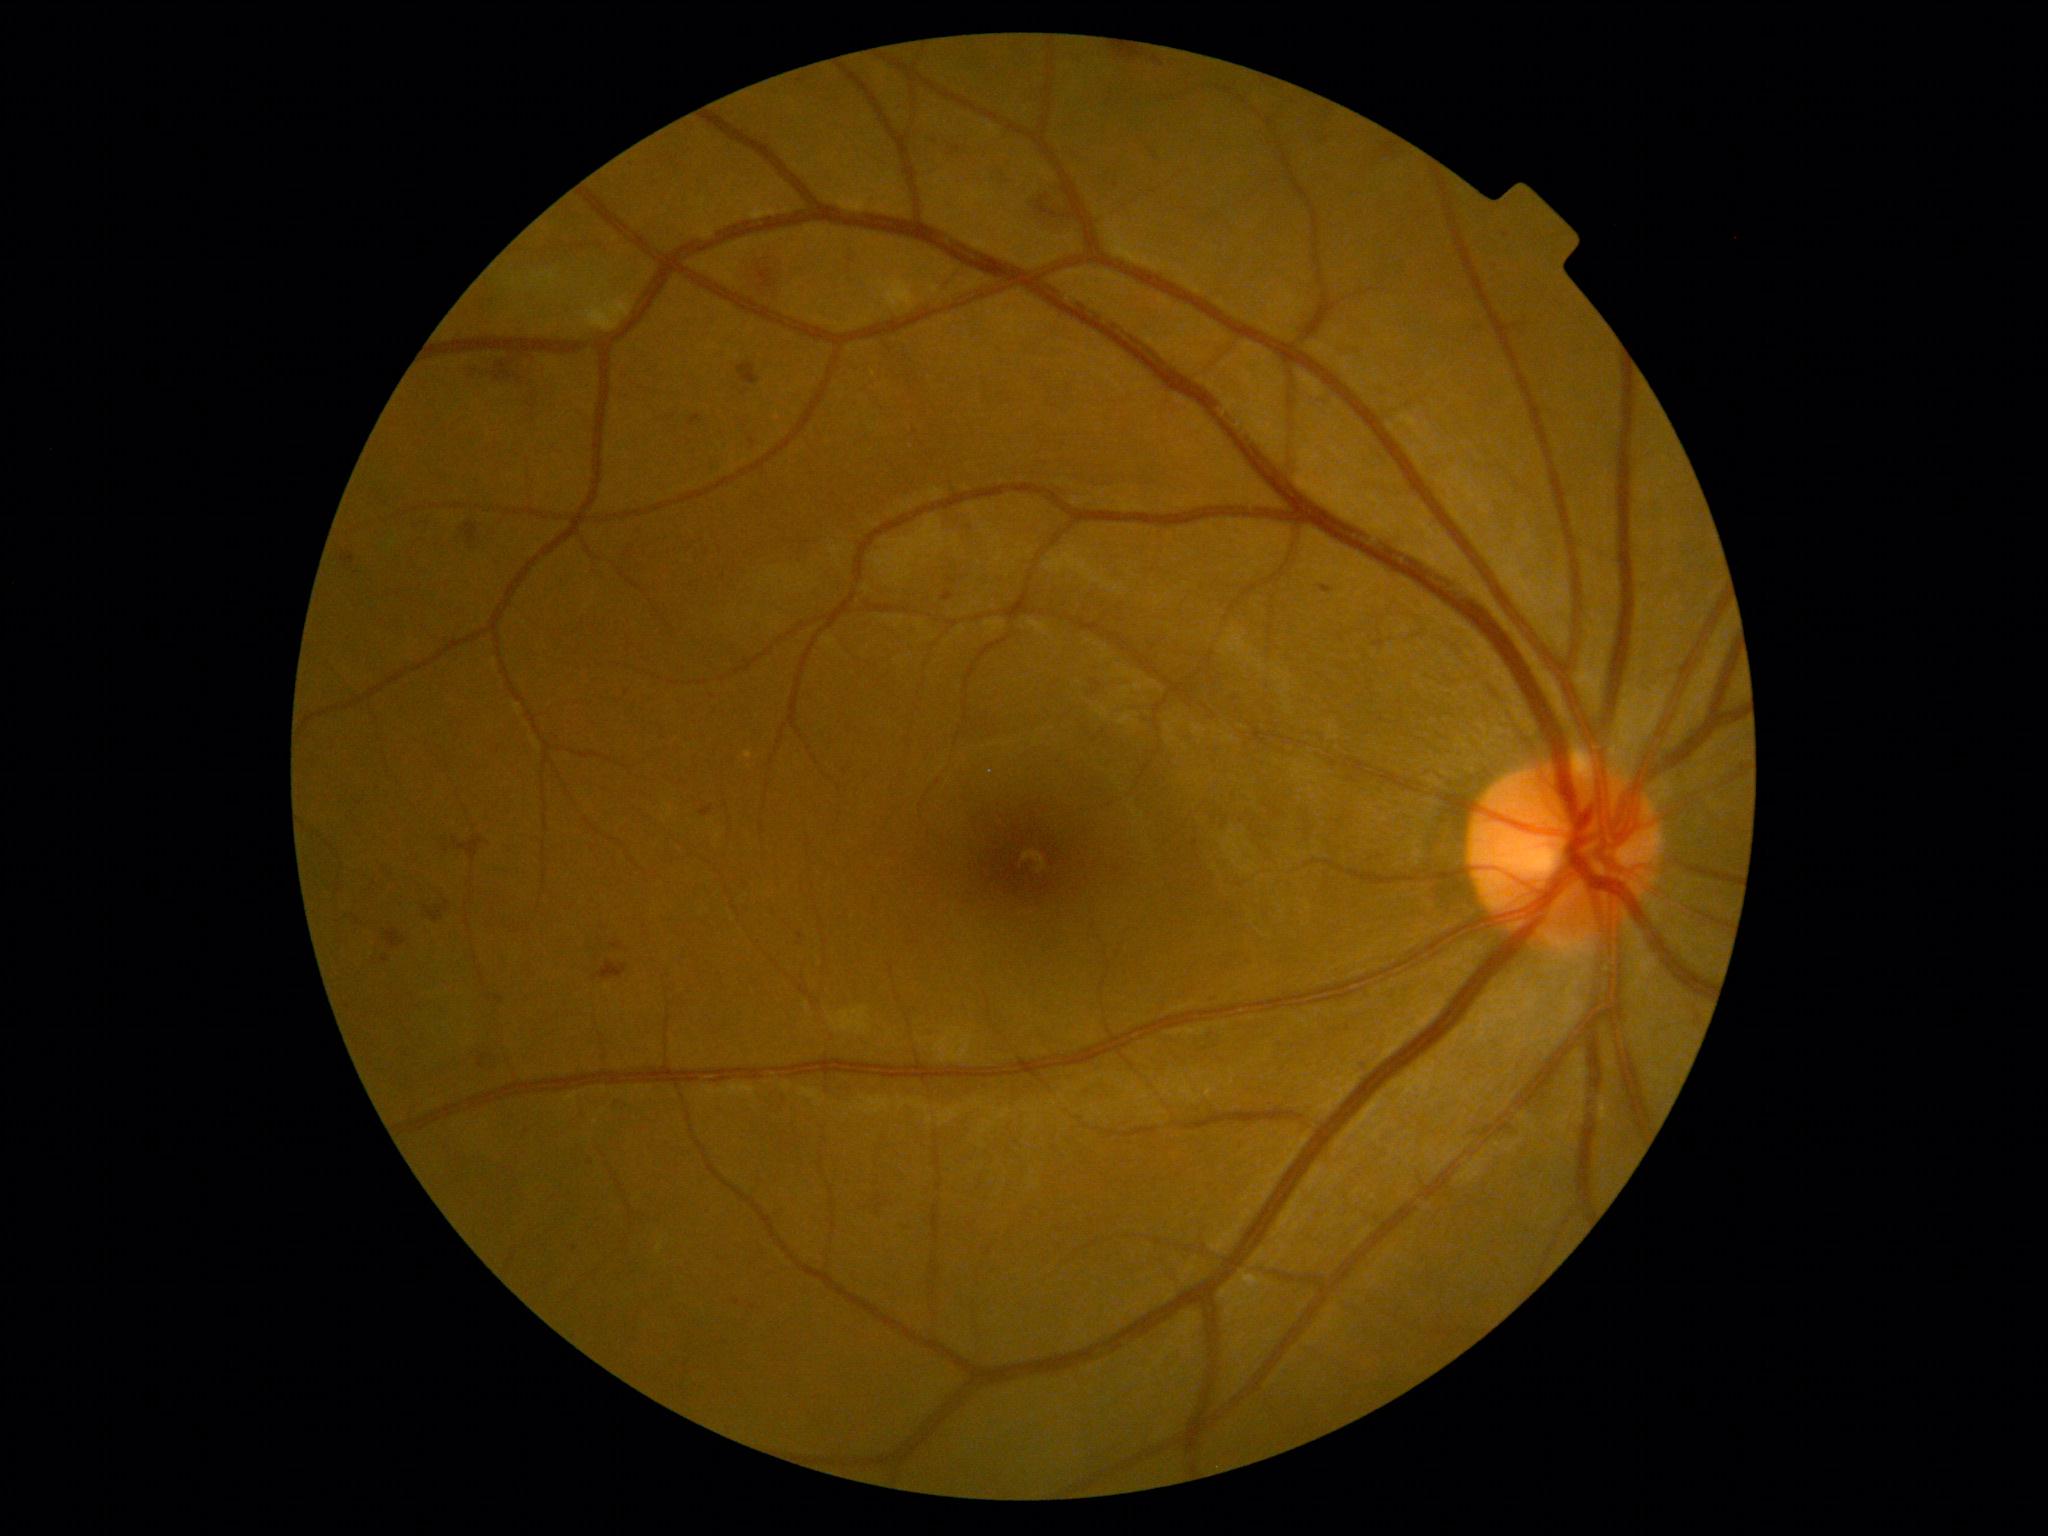

DR grade: moderate NPDR (2).